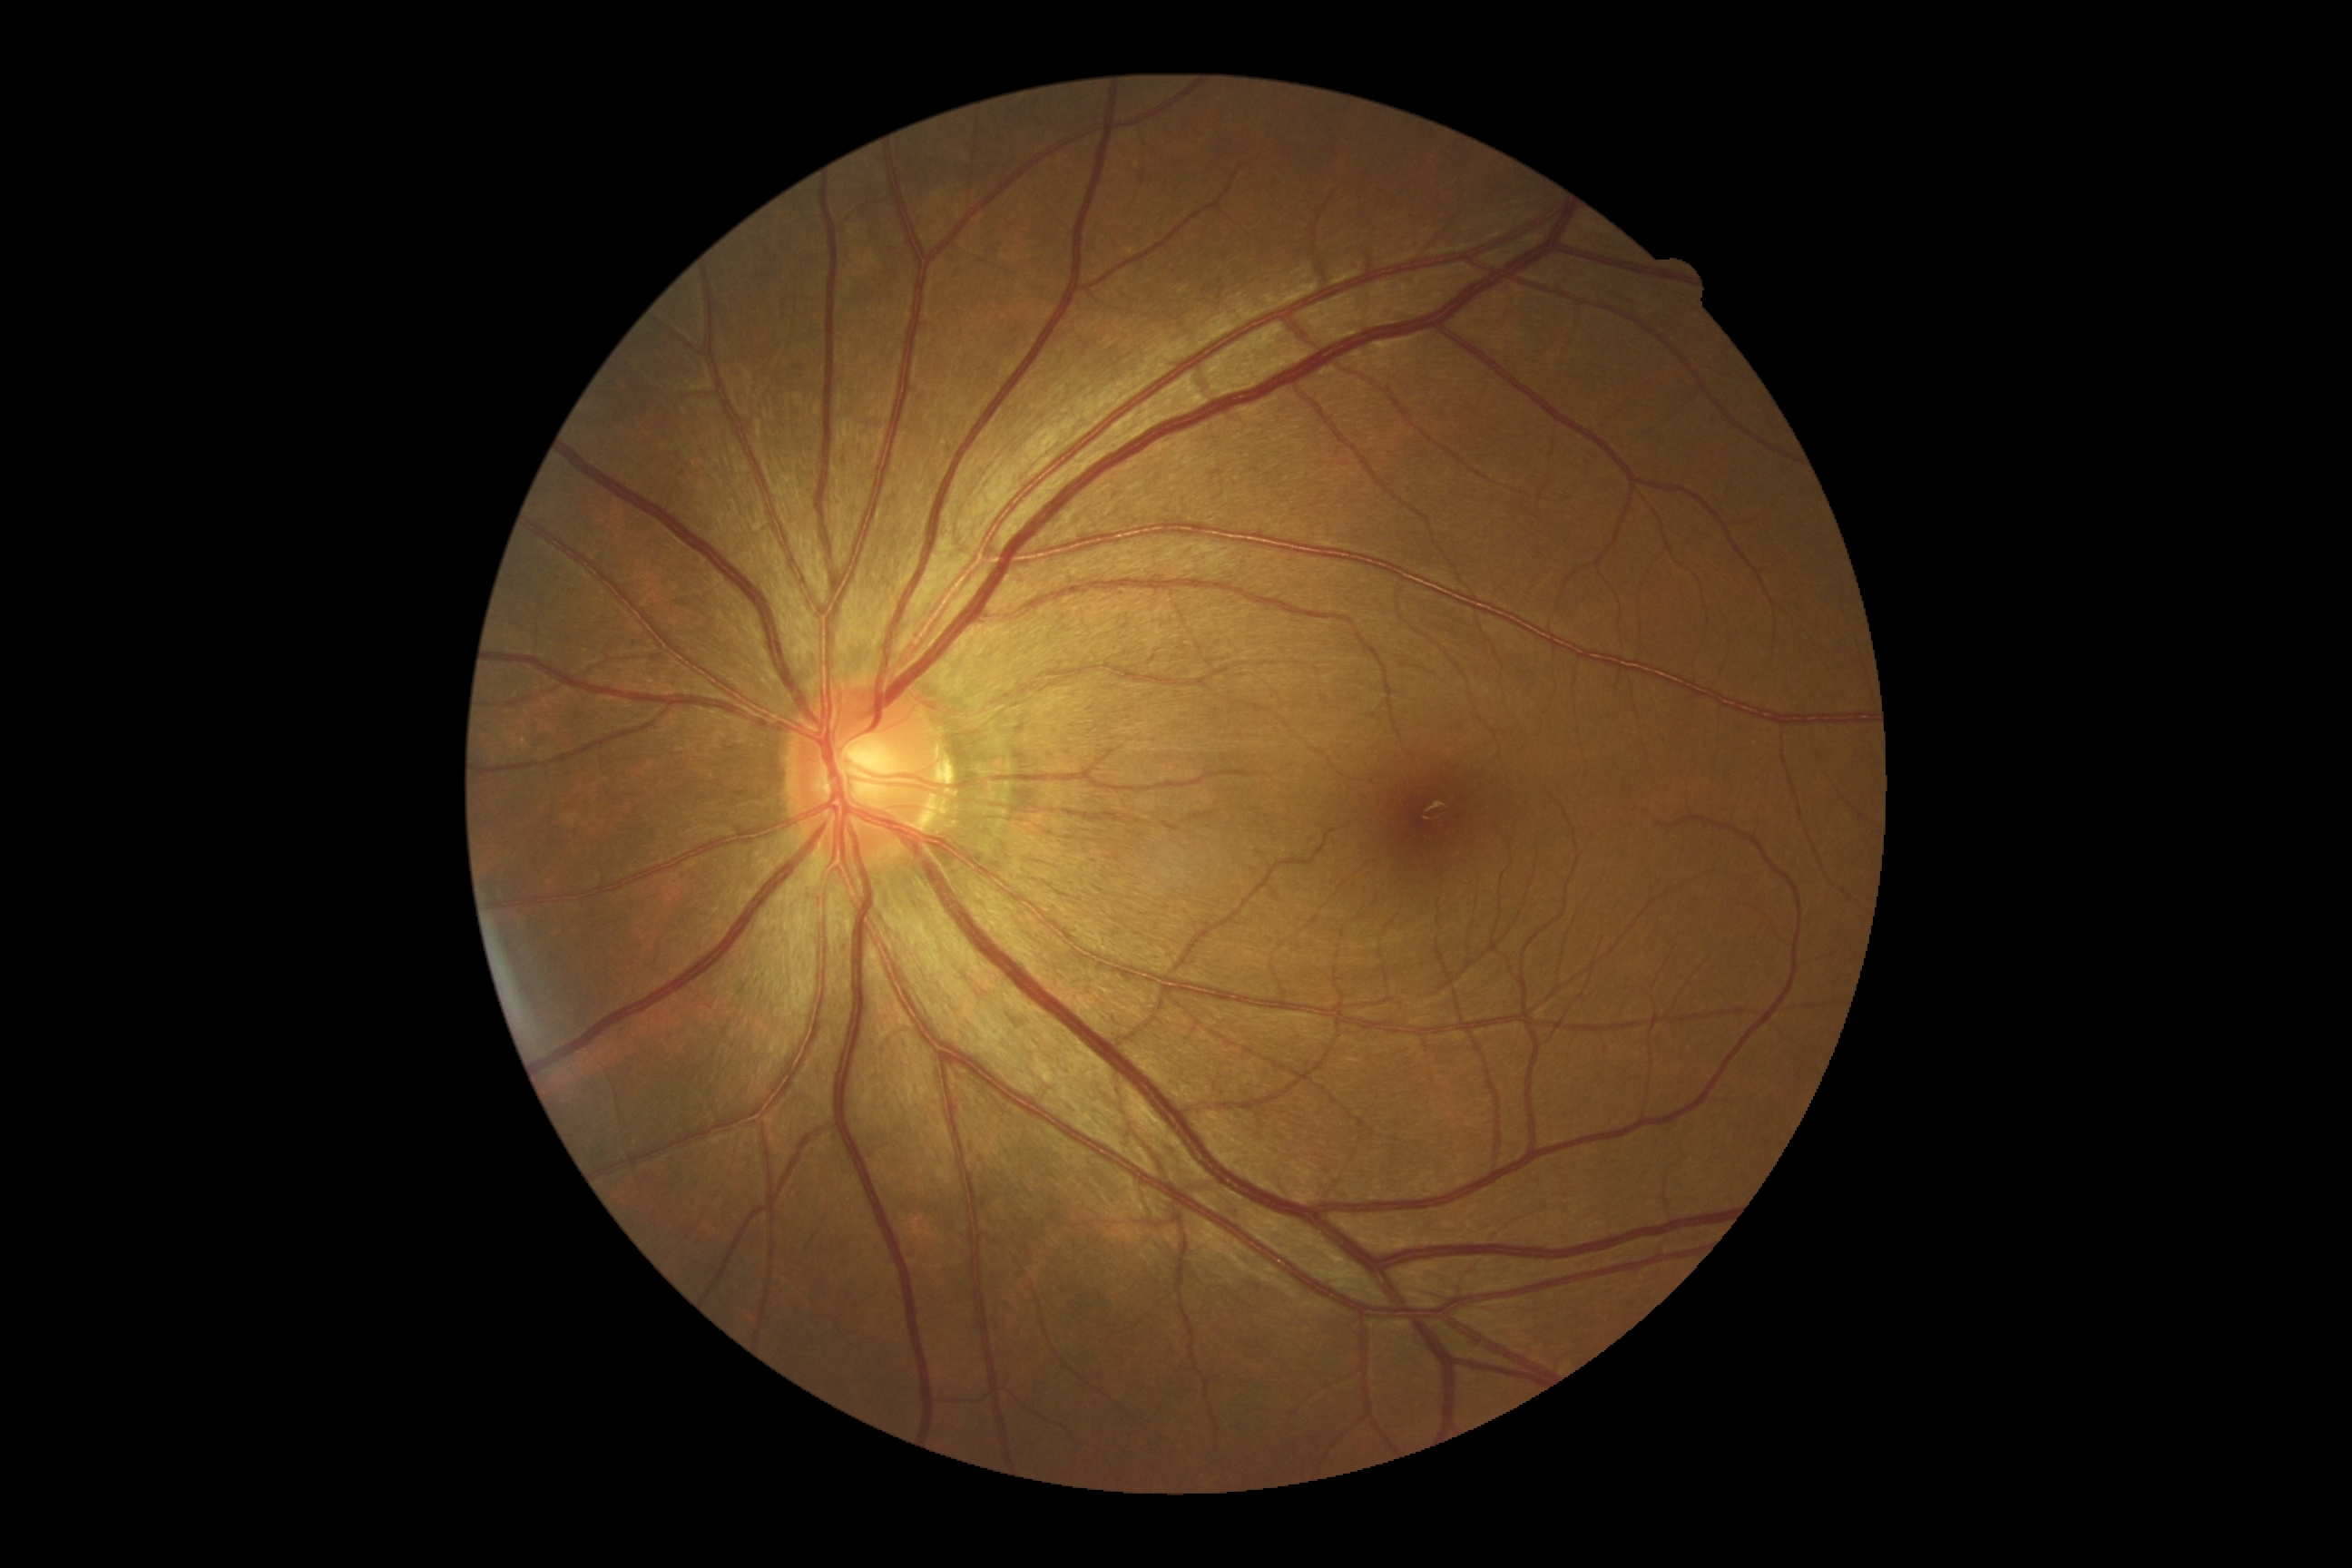

{"dr_grade": "0"}